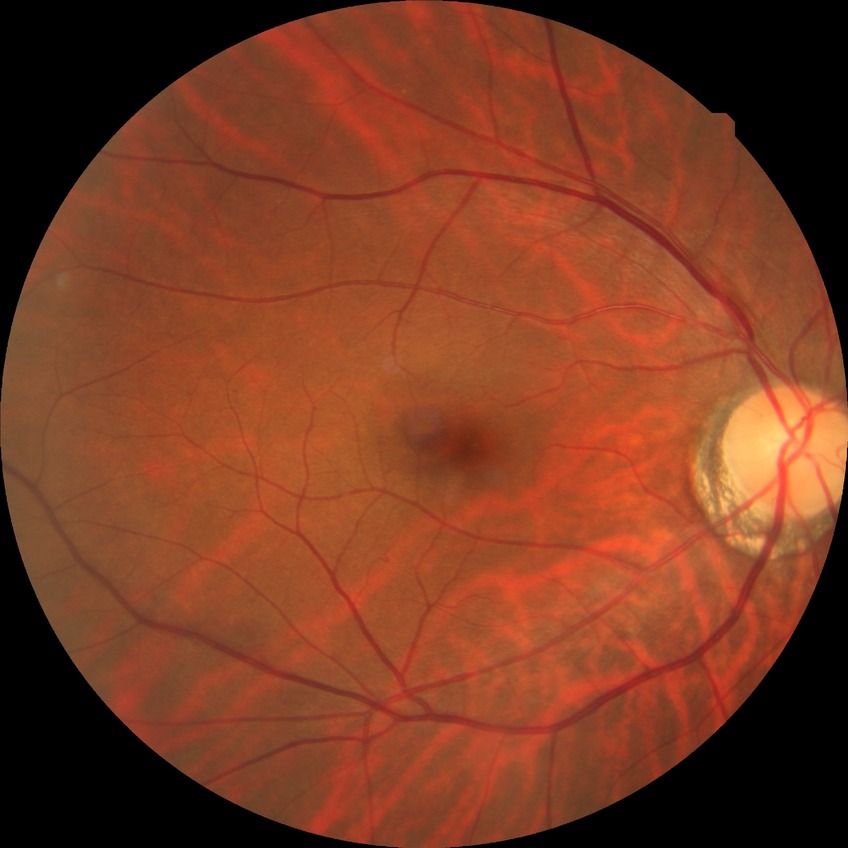
  davis_grade: no diabetic retinopathy (NDR)